Image size 2228x1652.
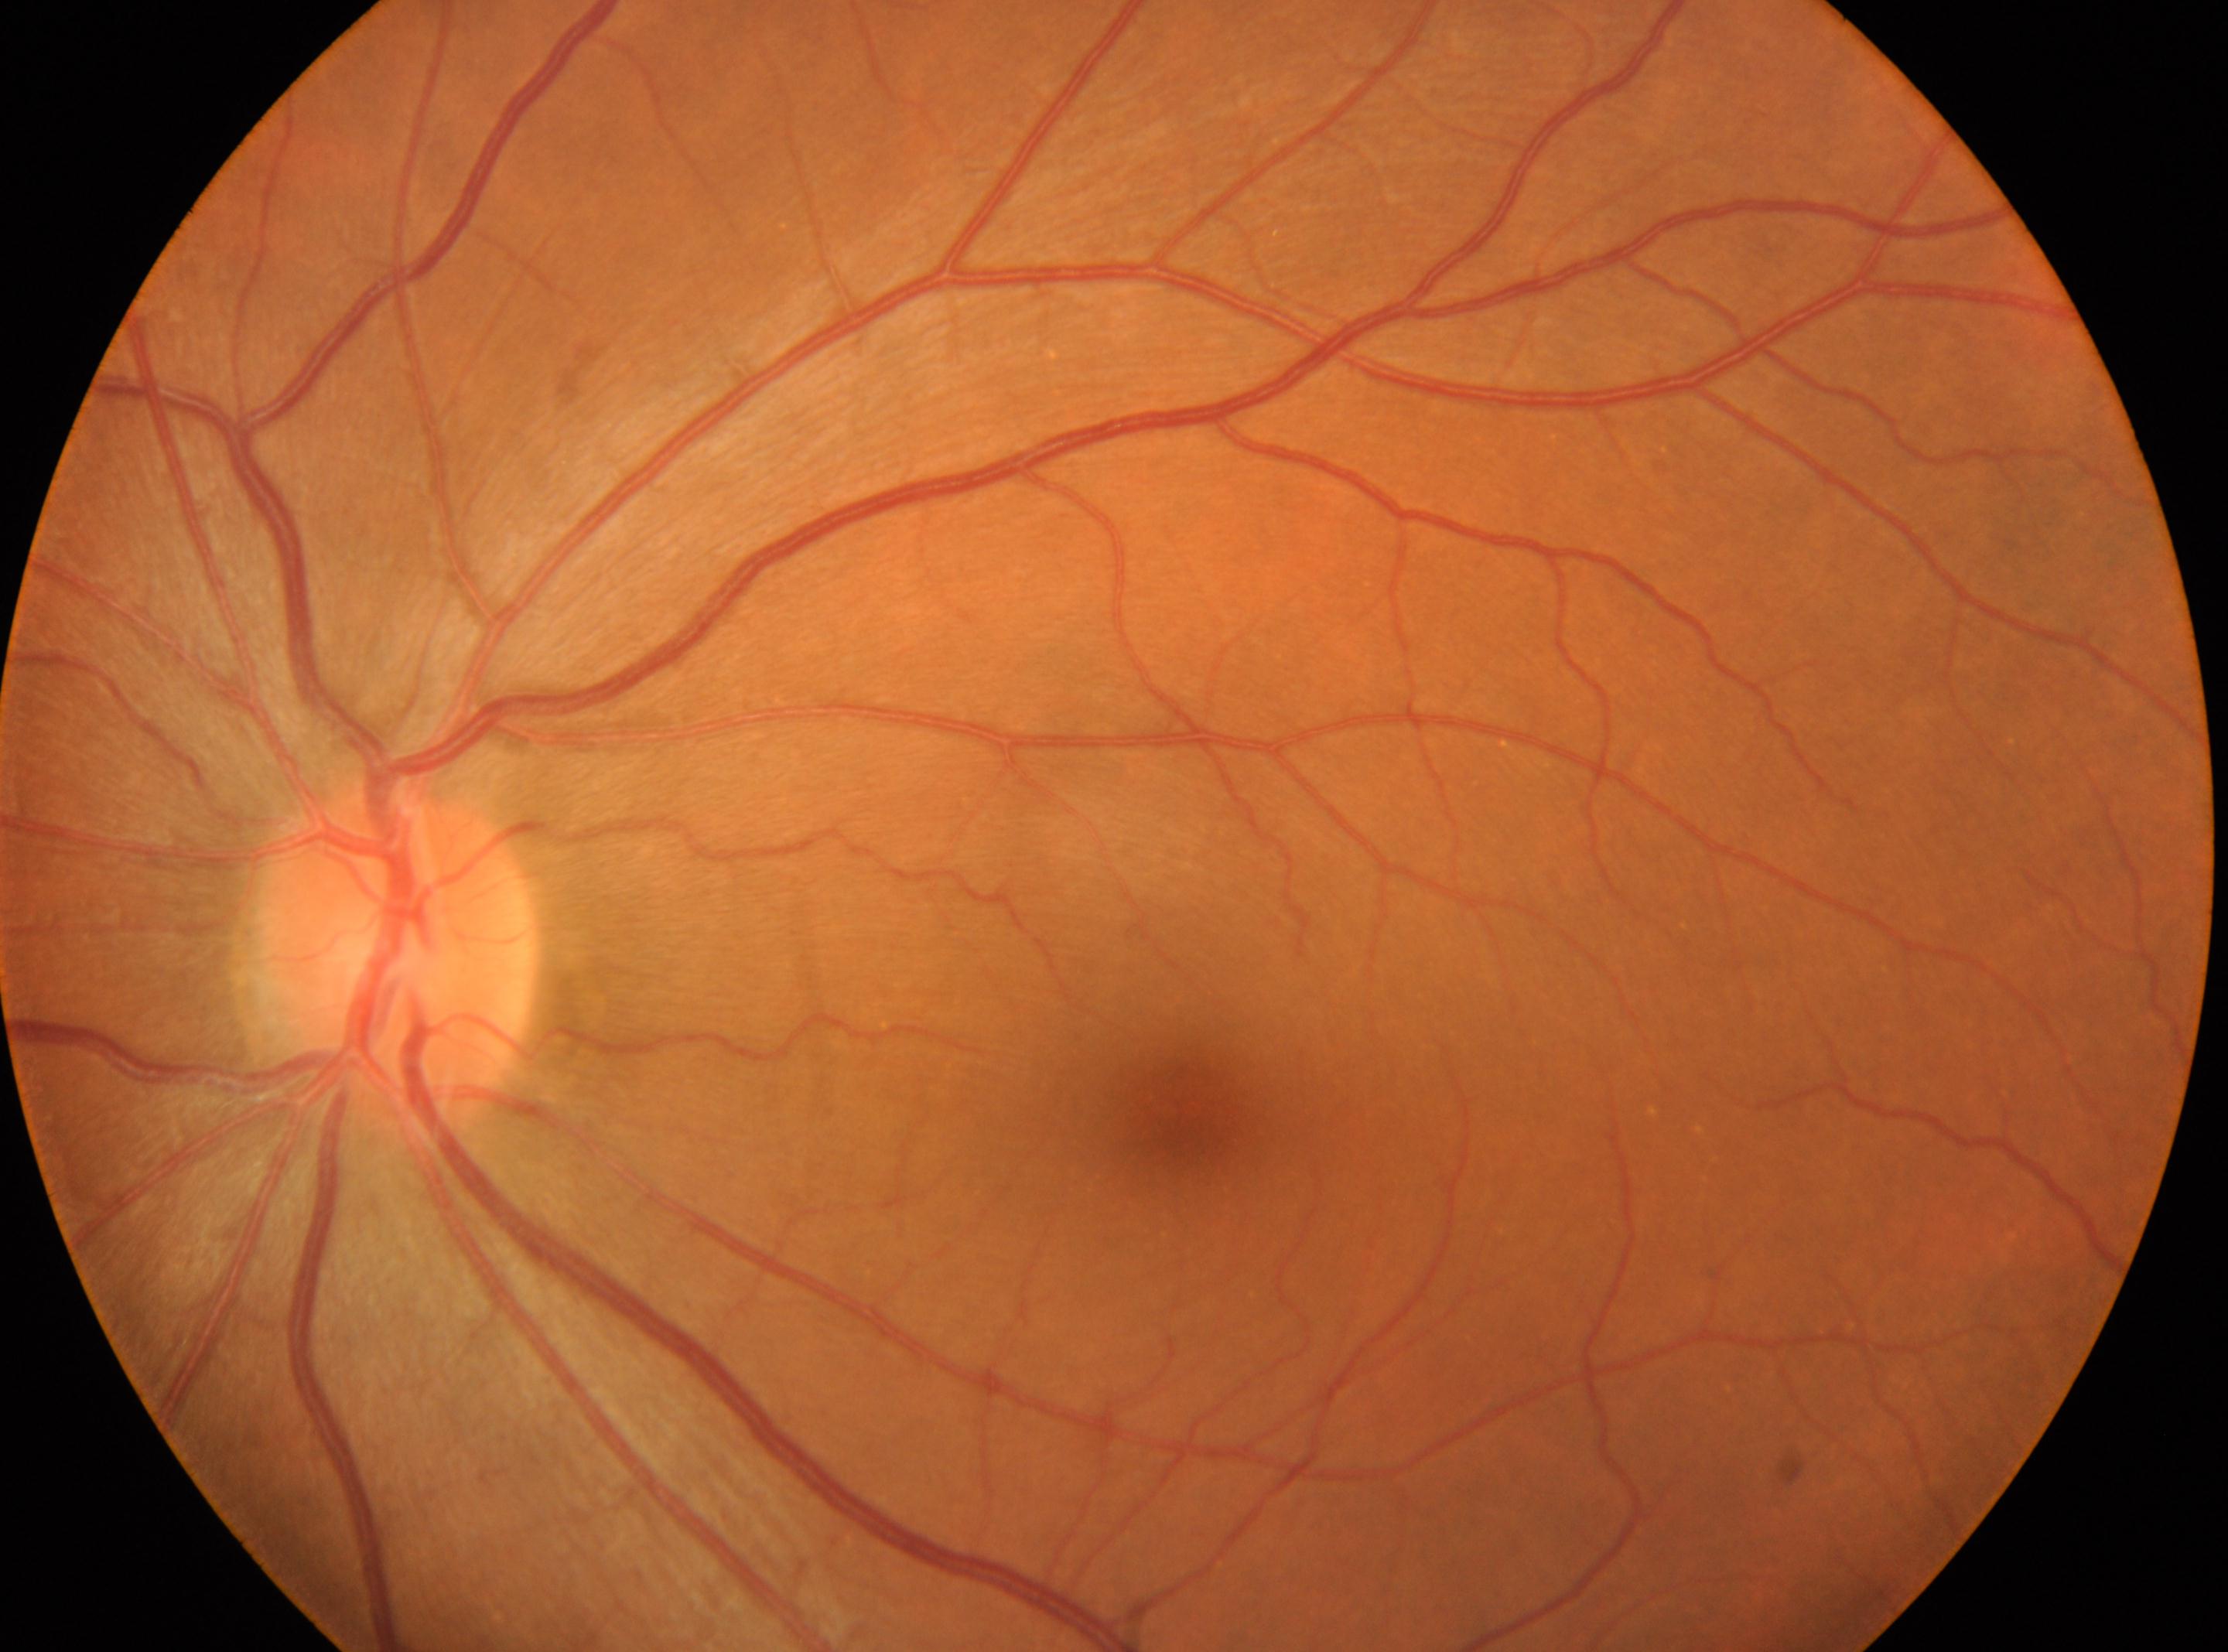 Diabetic retinopathy severity is 0/4.
The fovea center is at x=1184, y=1120.
No diabetic retinal disease findings.
Optic disk: x=400, y=961.
Imaged eye: OS.